45 degree fundus photograph. Diabetic retinopathy graded by the modified Davis classification. Camera: NIDEK AFC-230:
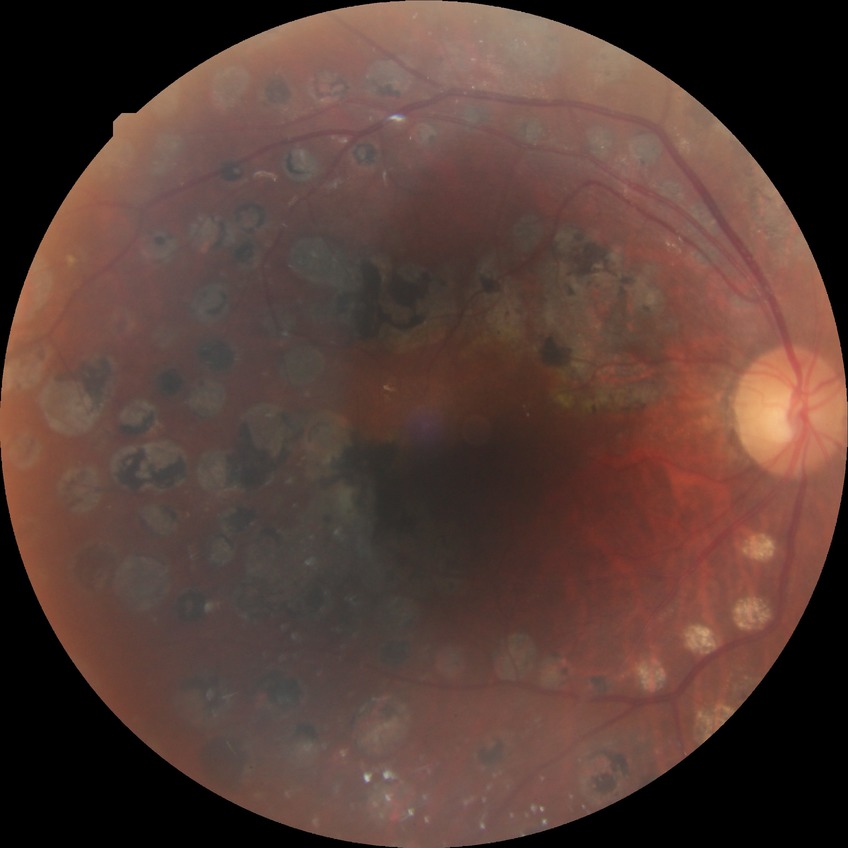 diabetic retinopathy stage: proliferative diabetic retinopathy.